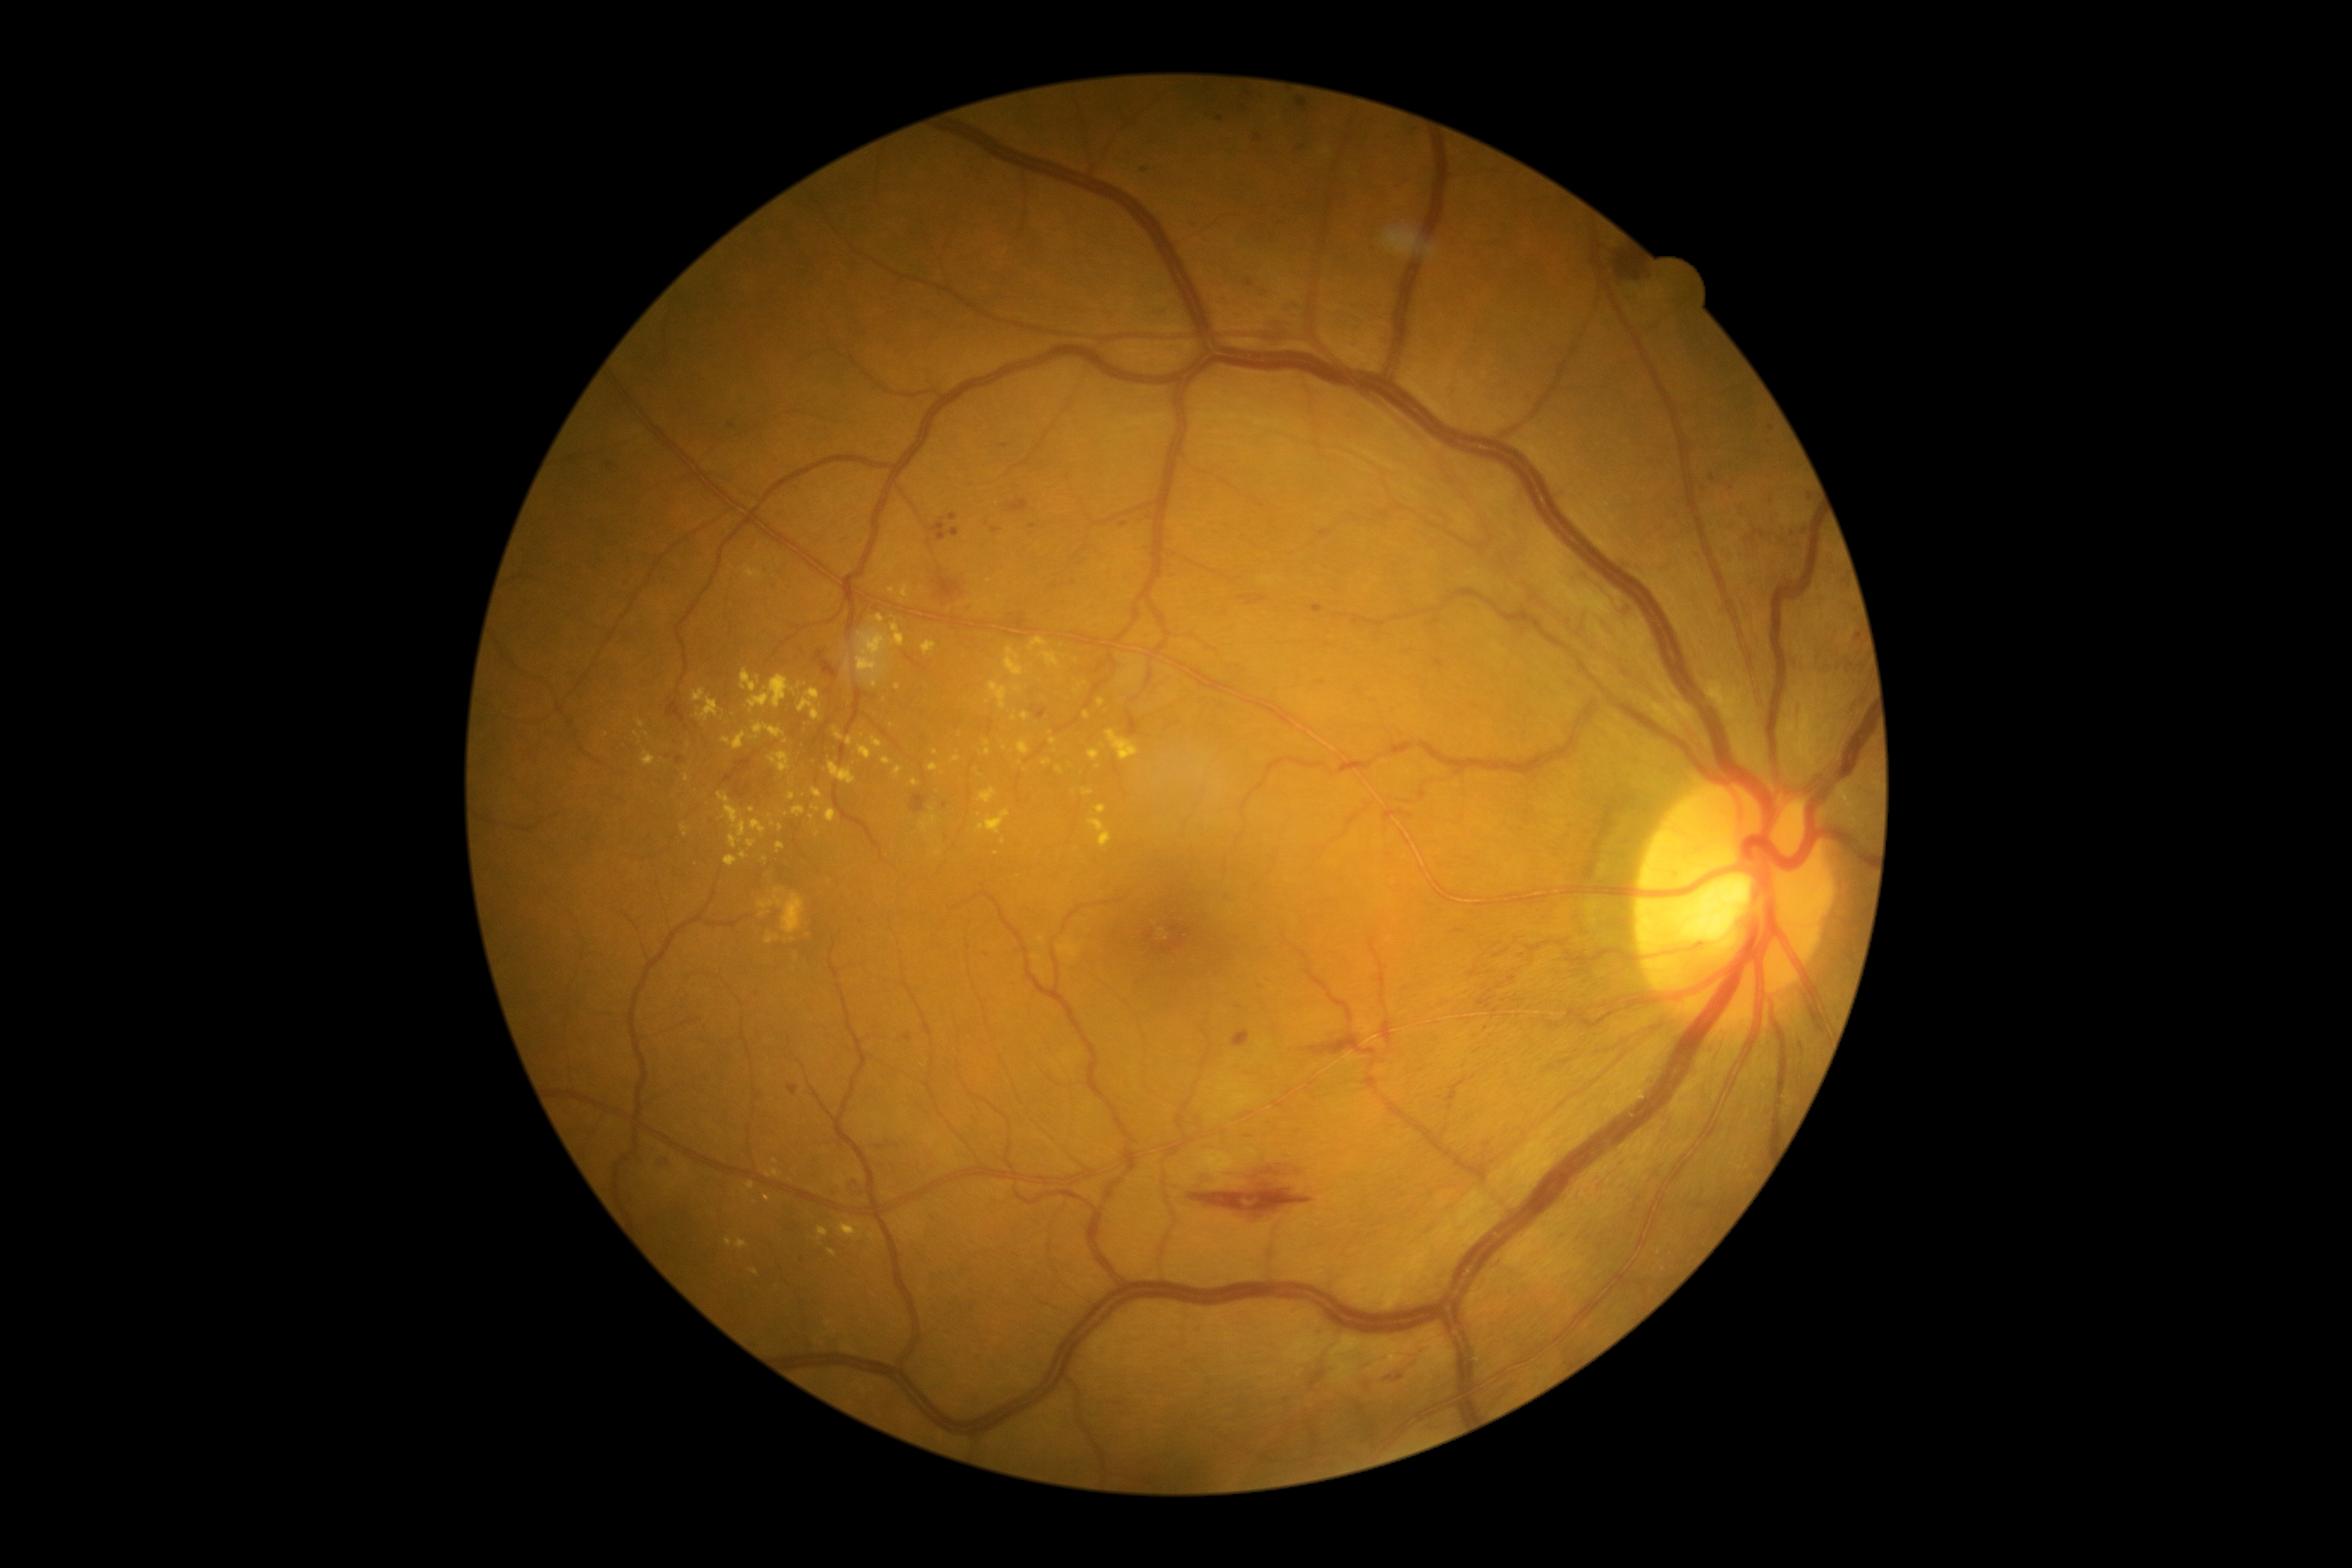

Diabetic retinopathy (DR): 2
Lesions identified (partial list):
• hard exudates (EXs) (partial): x1=754 y1=725 x2=785 y2=738 | x1=747 y1=1182 x2=756 y2=1189 | x1=1106 y1=732 x2=1139 y2=761 | x1=642 y1=752 x2=656 y2=768 | x1=1087 y1=750 x2=1101 y2=761 | x1=874 y1=615 x2=885 y2=623 | x1=1014 y1=687 x2=1022 y2=694 | x1=776 y1=842 x2=785 y2=854 | x1=759 y1=912 x2=768 y2=917 | x1=725 y1=855 x2=738 y2=867 | x1=726 y1=1237 x2=733 y2=1247 | x1=1005 y1=647 x2=1024 y2=677
• Small EXs near (x=767, y=1197) | (x=1080, y=687) | (x=891, y=726) | (x=881, y=557) | (x=1131, y=659) | (x=785, y=742) | (x=1181, y=531)